1440 x 1080 pixels; infant wide-field fundus photograph.
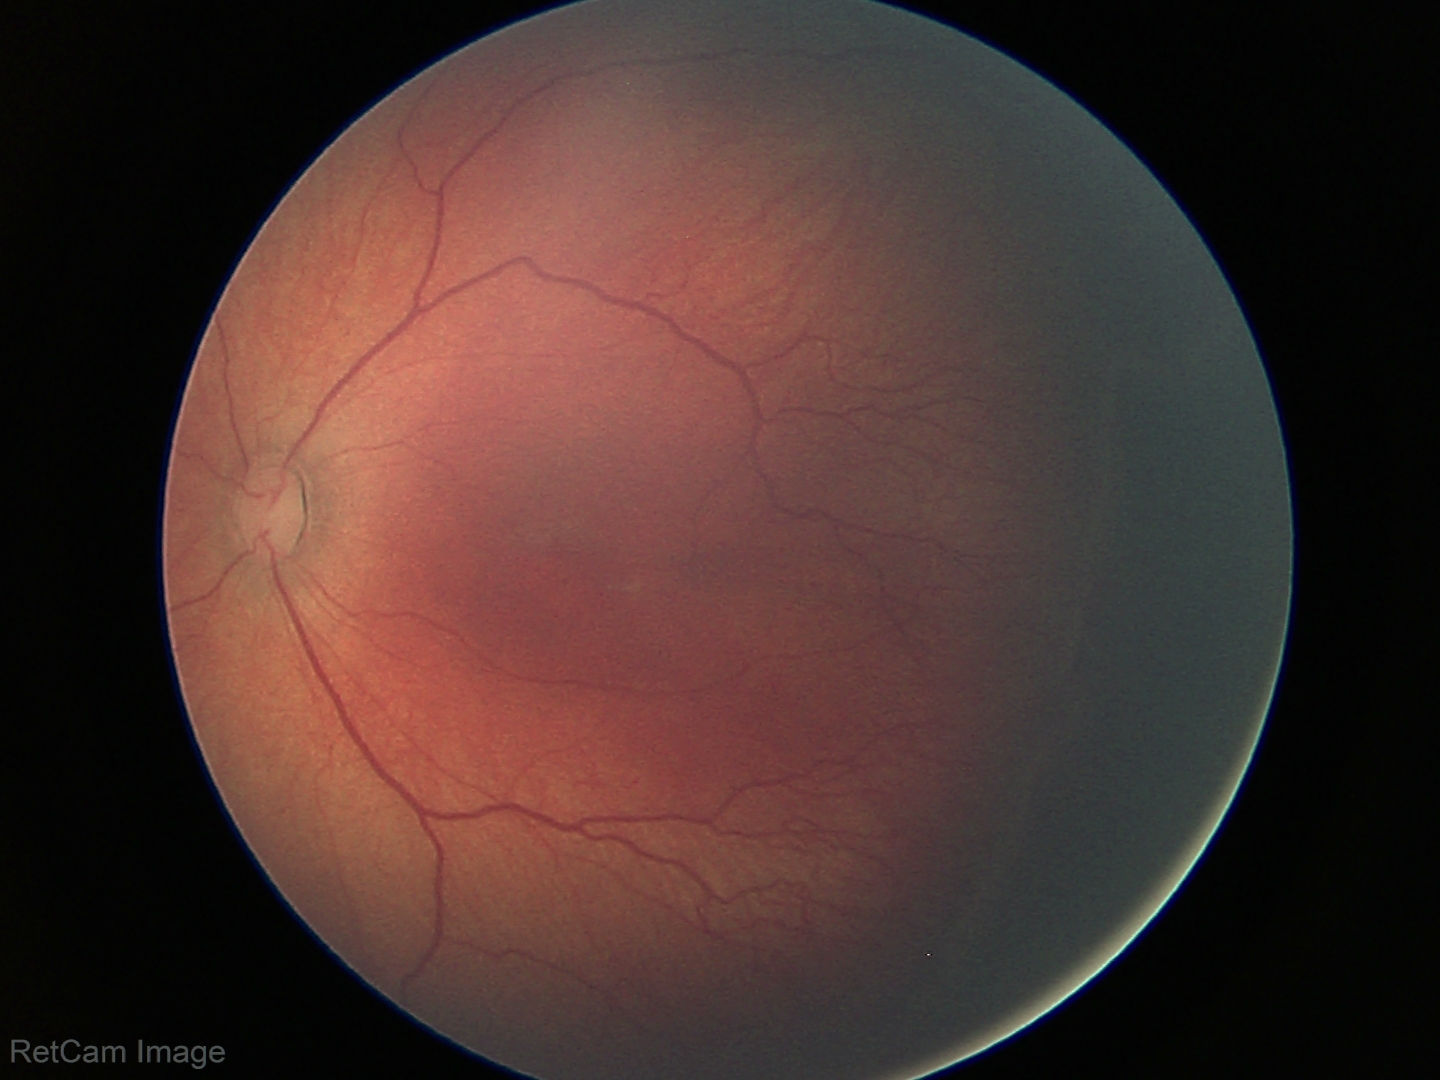
Diagnosis from this screening exam: retinopathy of prematurity stage 2.
No plus disease.